Topcon TRC retinal camera, IMAGEnet capture system; fundus photograph cropped around the optic nerve head: 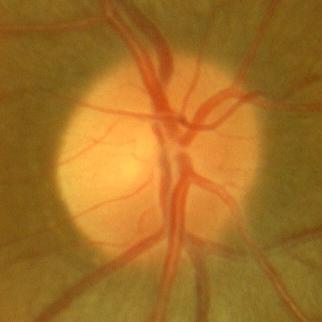 Glaucoma assessment: no glaucomatous changes.